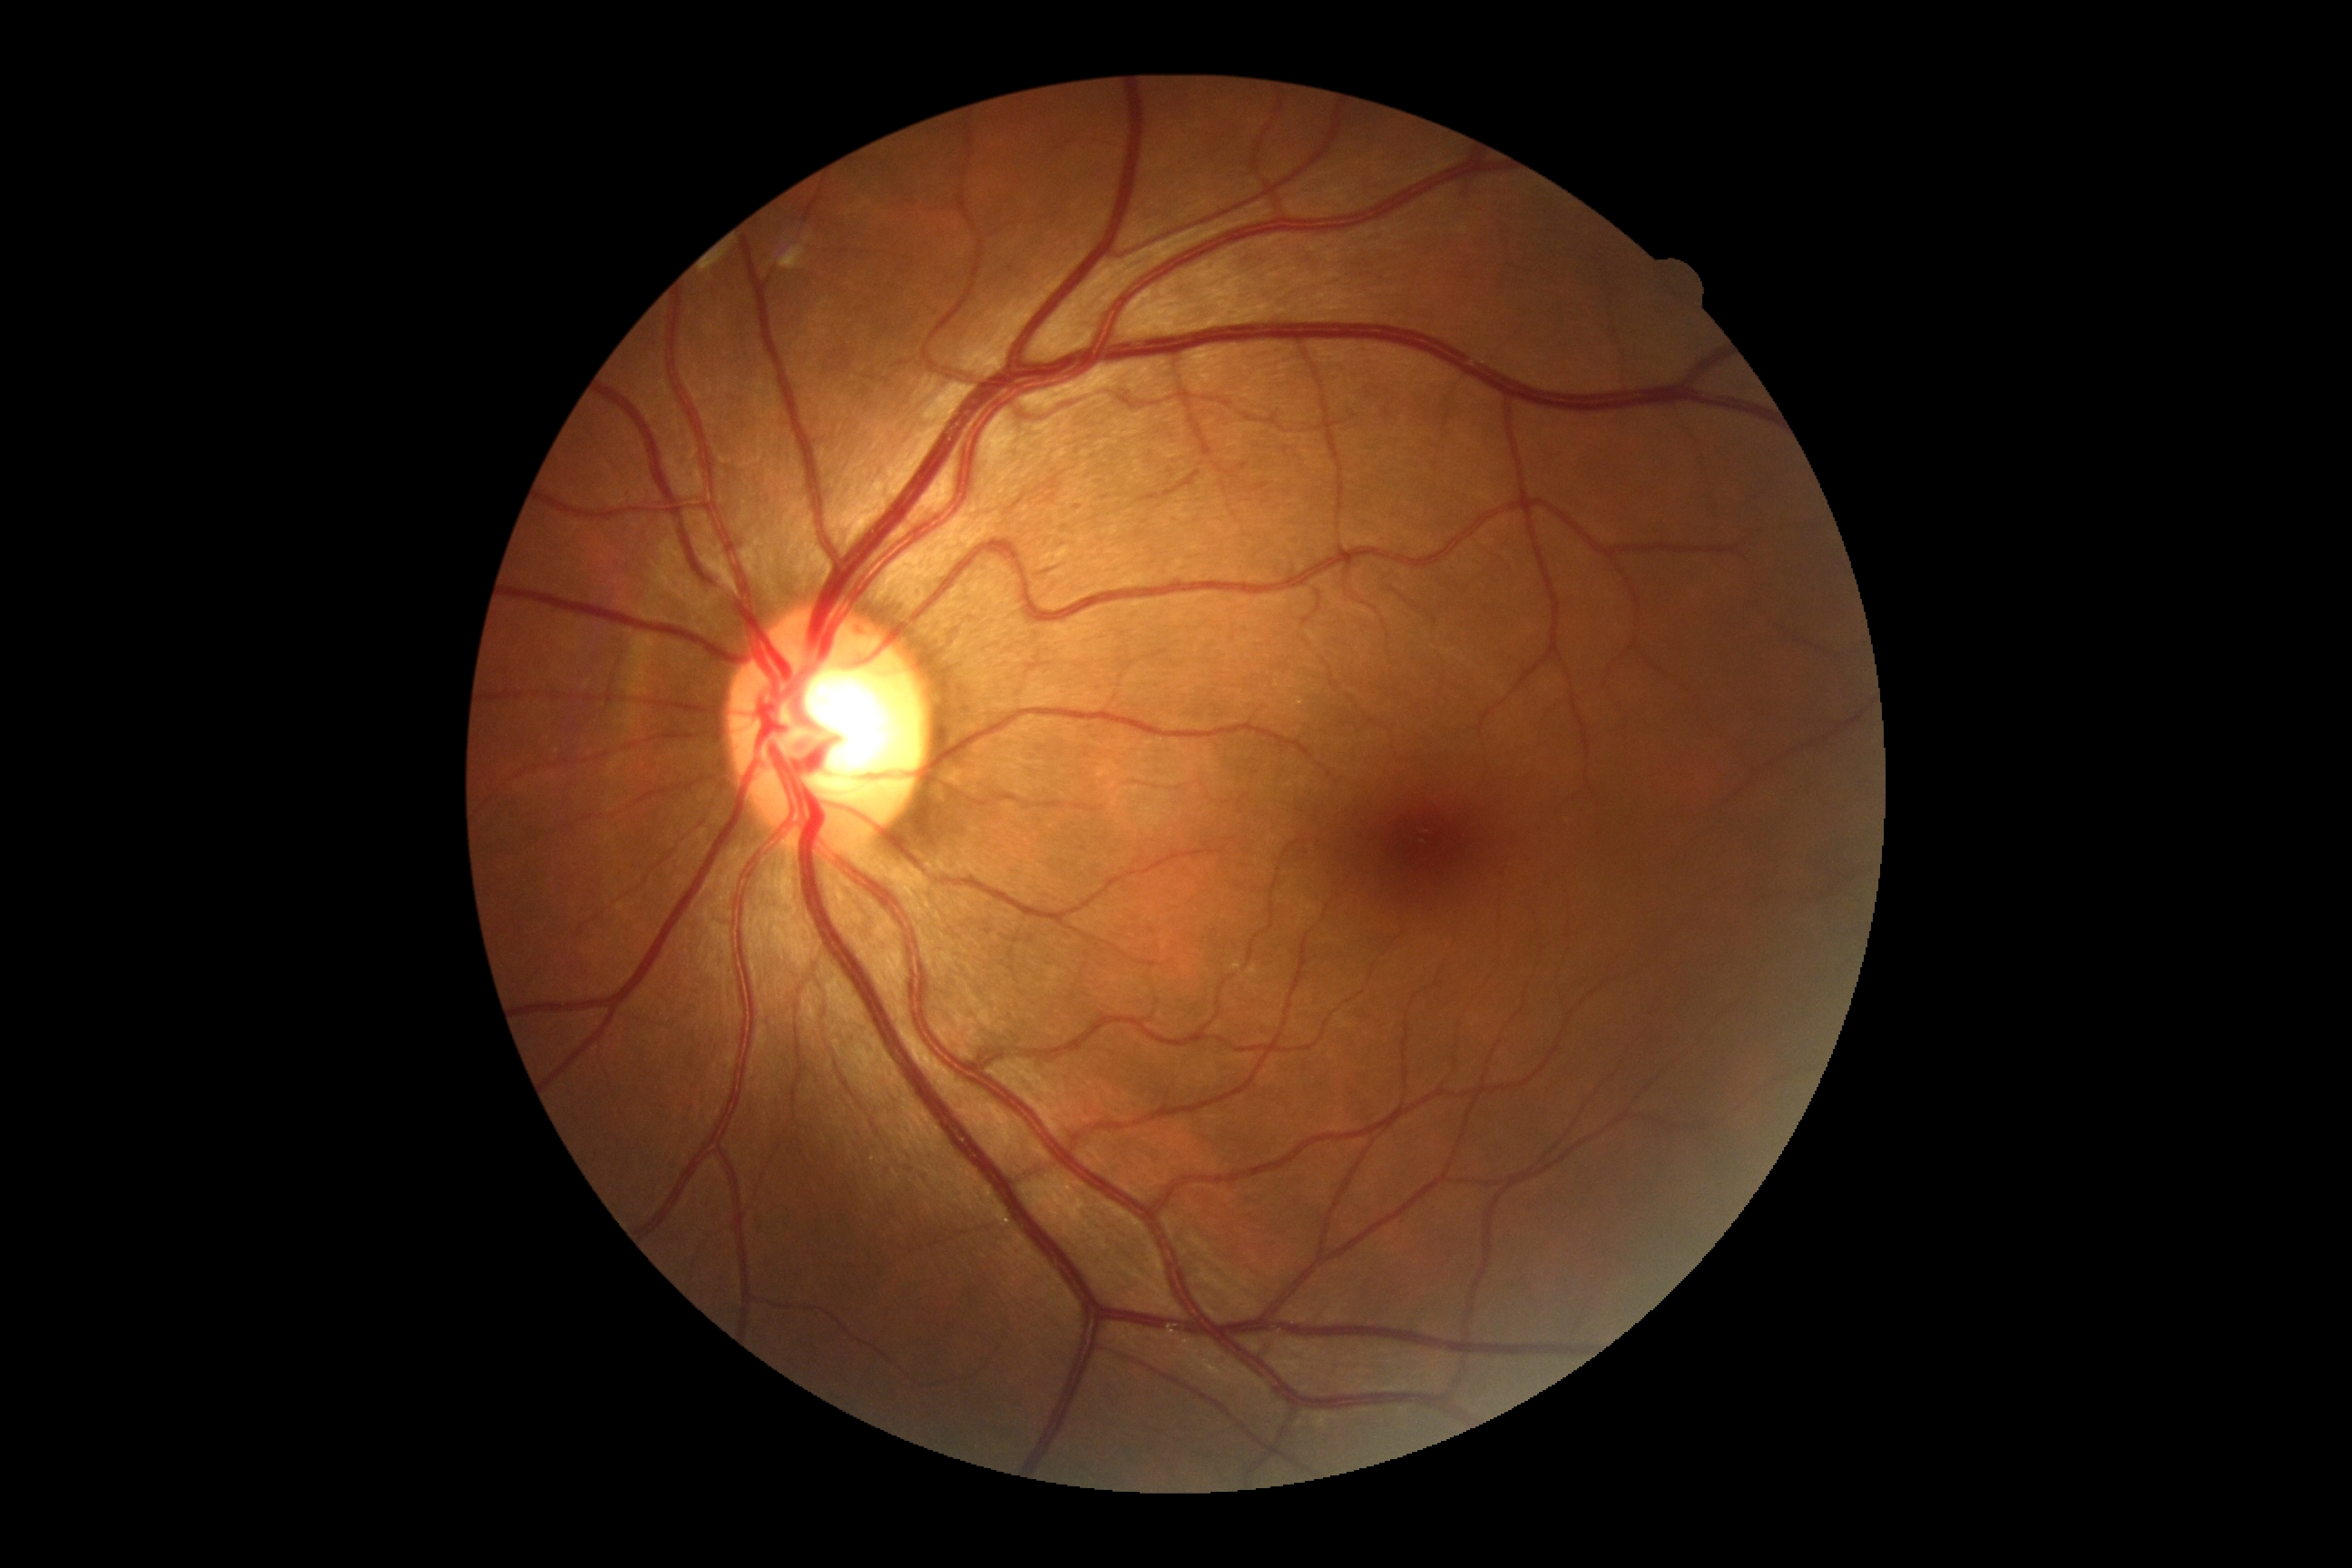 Diabetic retinopathy grade is no apparent retinopathy (0) — no visible signs of diabetic retinopathy.